45° FOV · NIDEK AFC-230 · color fundus photograph: 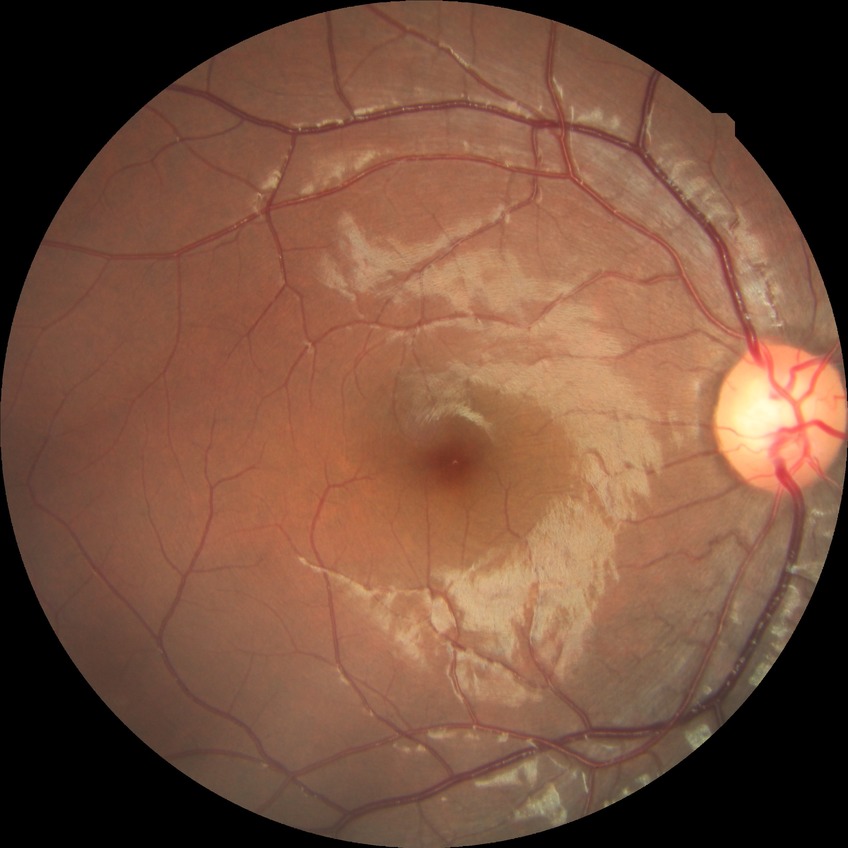 diabetic retinopathy (DR)=no diabetic retinopathy (NDR).